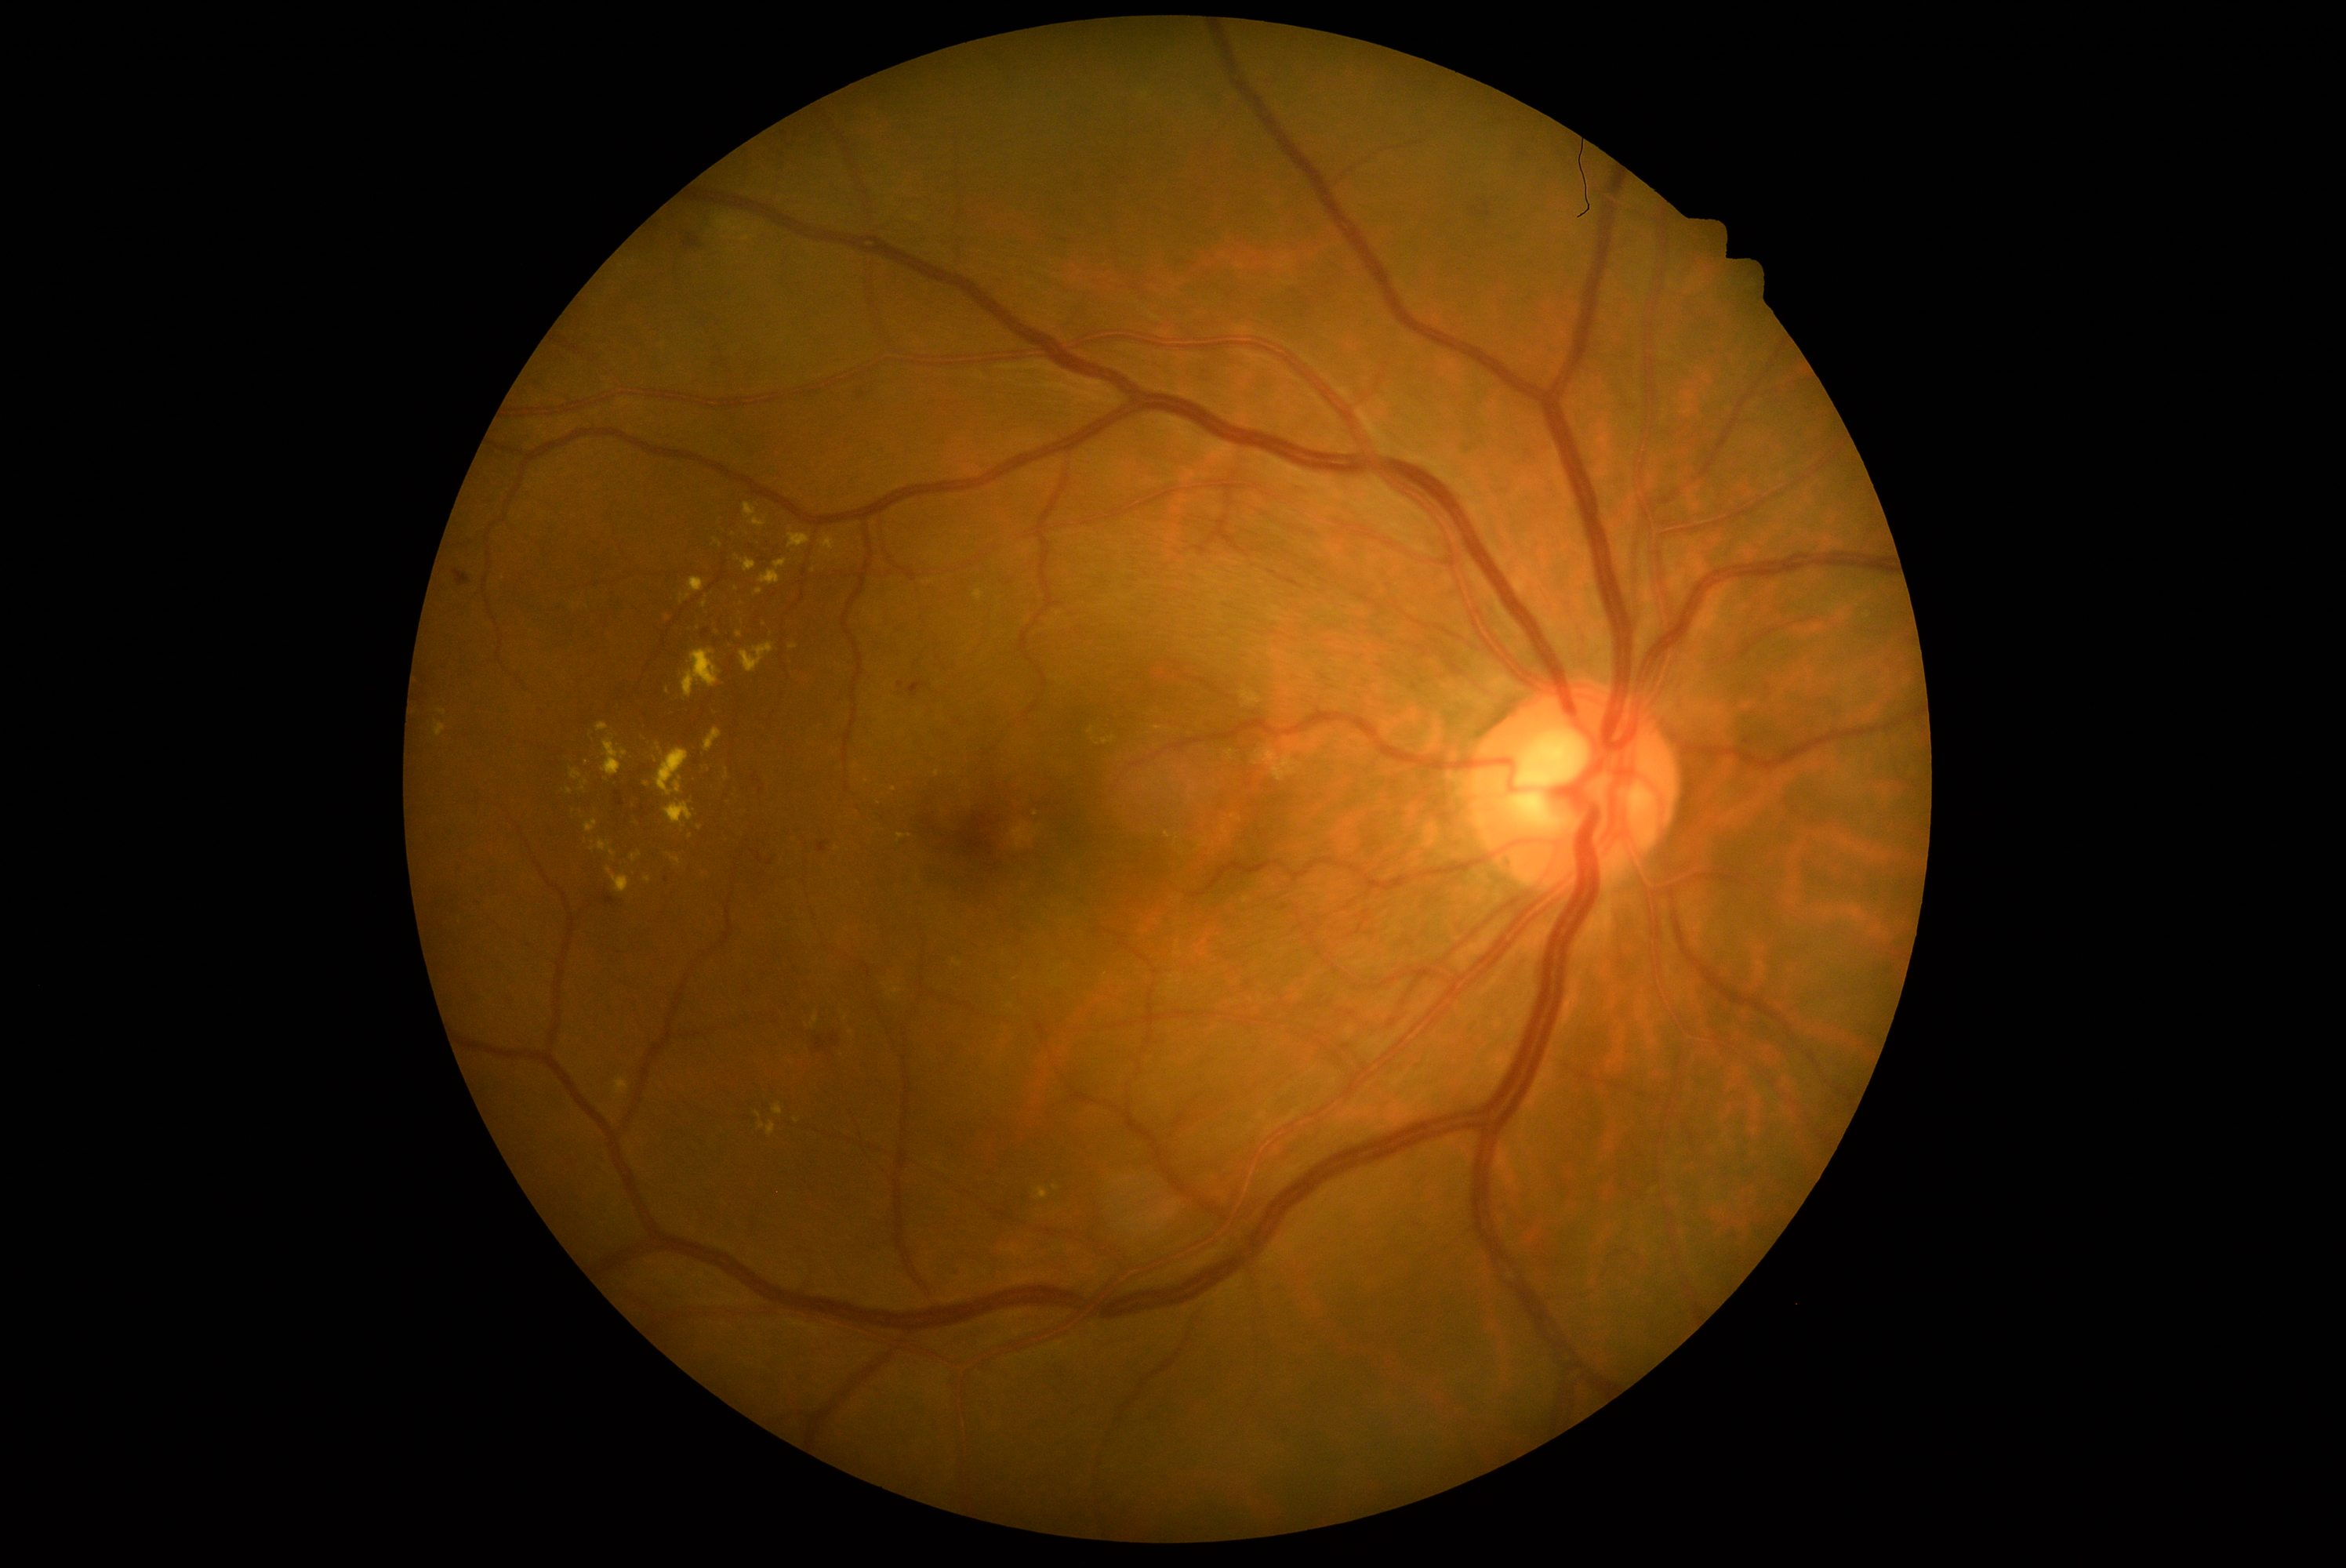 <lesions partial="true">
  <dr_grade>2</dr_grade>
  <ex partial="true">597, 841, 611, 852 | 658, 749, 664, 757 | 823, 537, 837, 551 | 601, 738, 628, 777 | 714, 540, 724, 548 | 680, 578, 705, 604 | 736, 556, 757, 573 | 738, 617, 743, 625 | 597, 724, 609, 733 | 790, 644, 799, 650 | 581, 780, 589, 793</ex>
  <ex_small_centers>pt(656, 761) | pt(647, 784) | pt(570, 792) | pt(586, 763)</ex_small_centers>
</lesions>